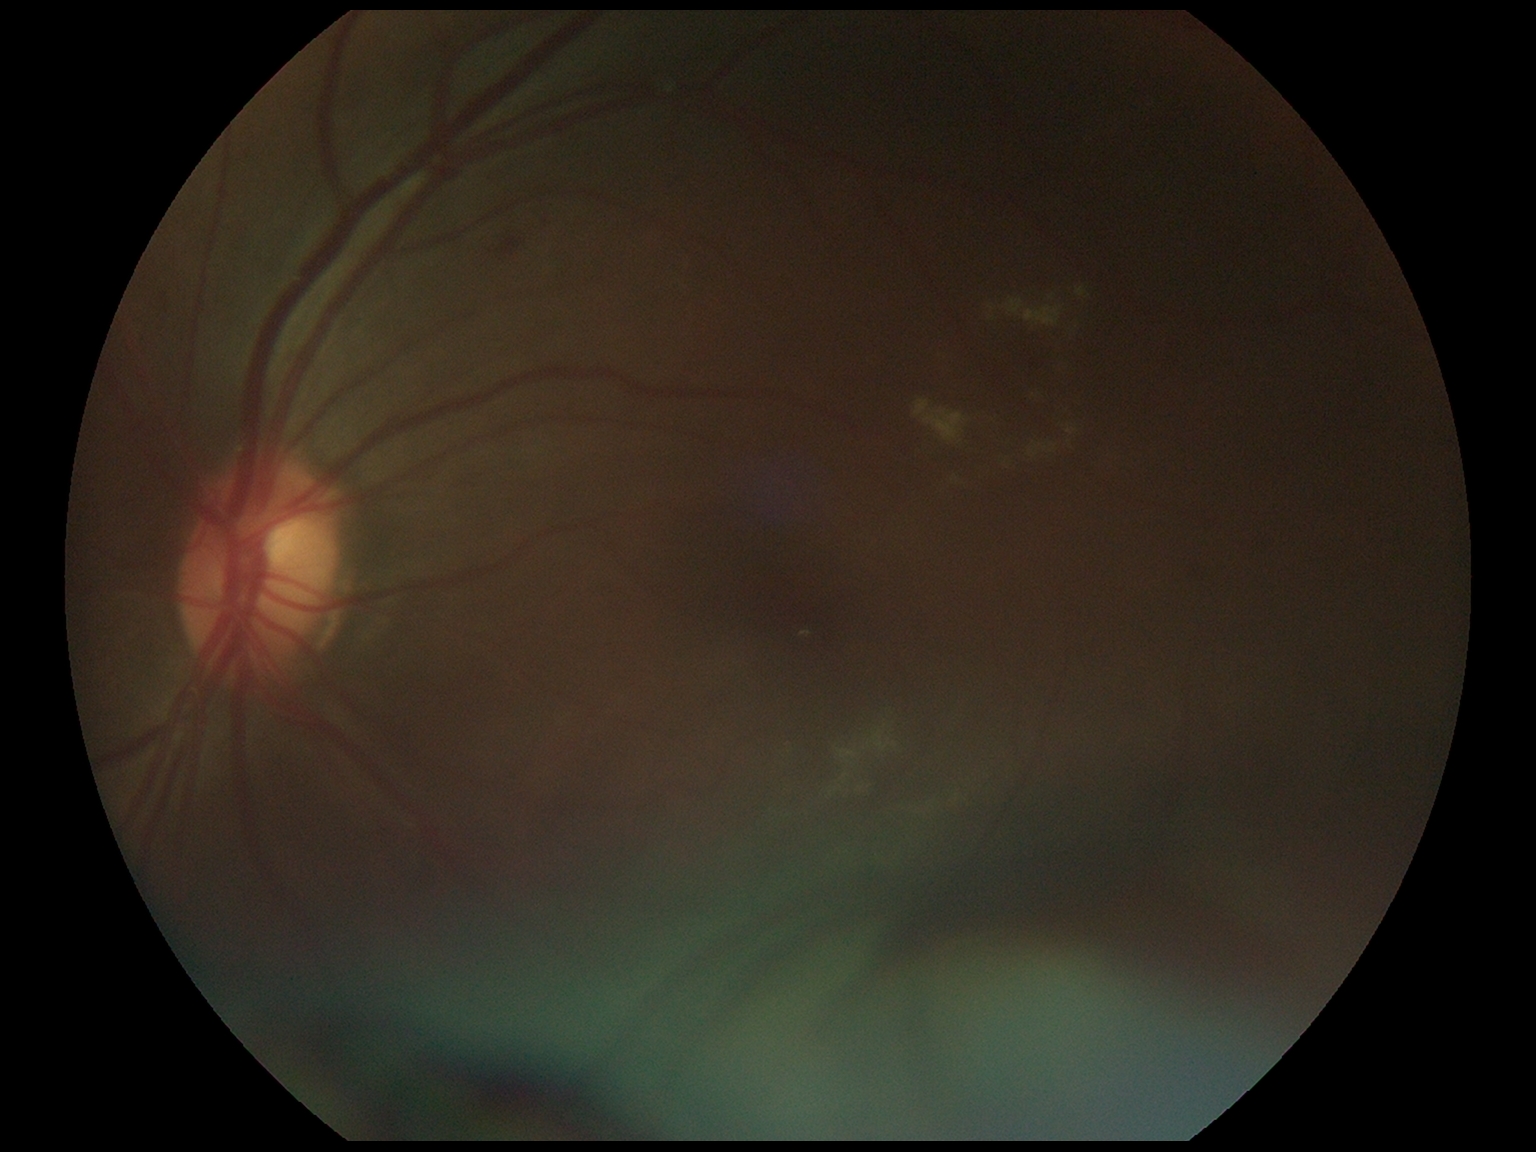
  dr_grade: 2